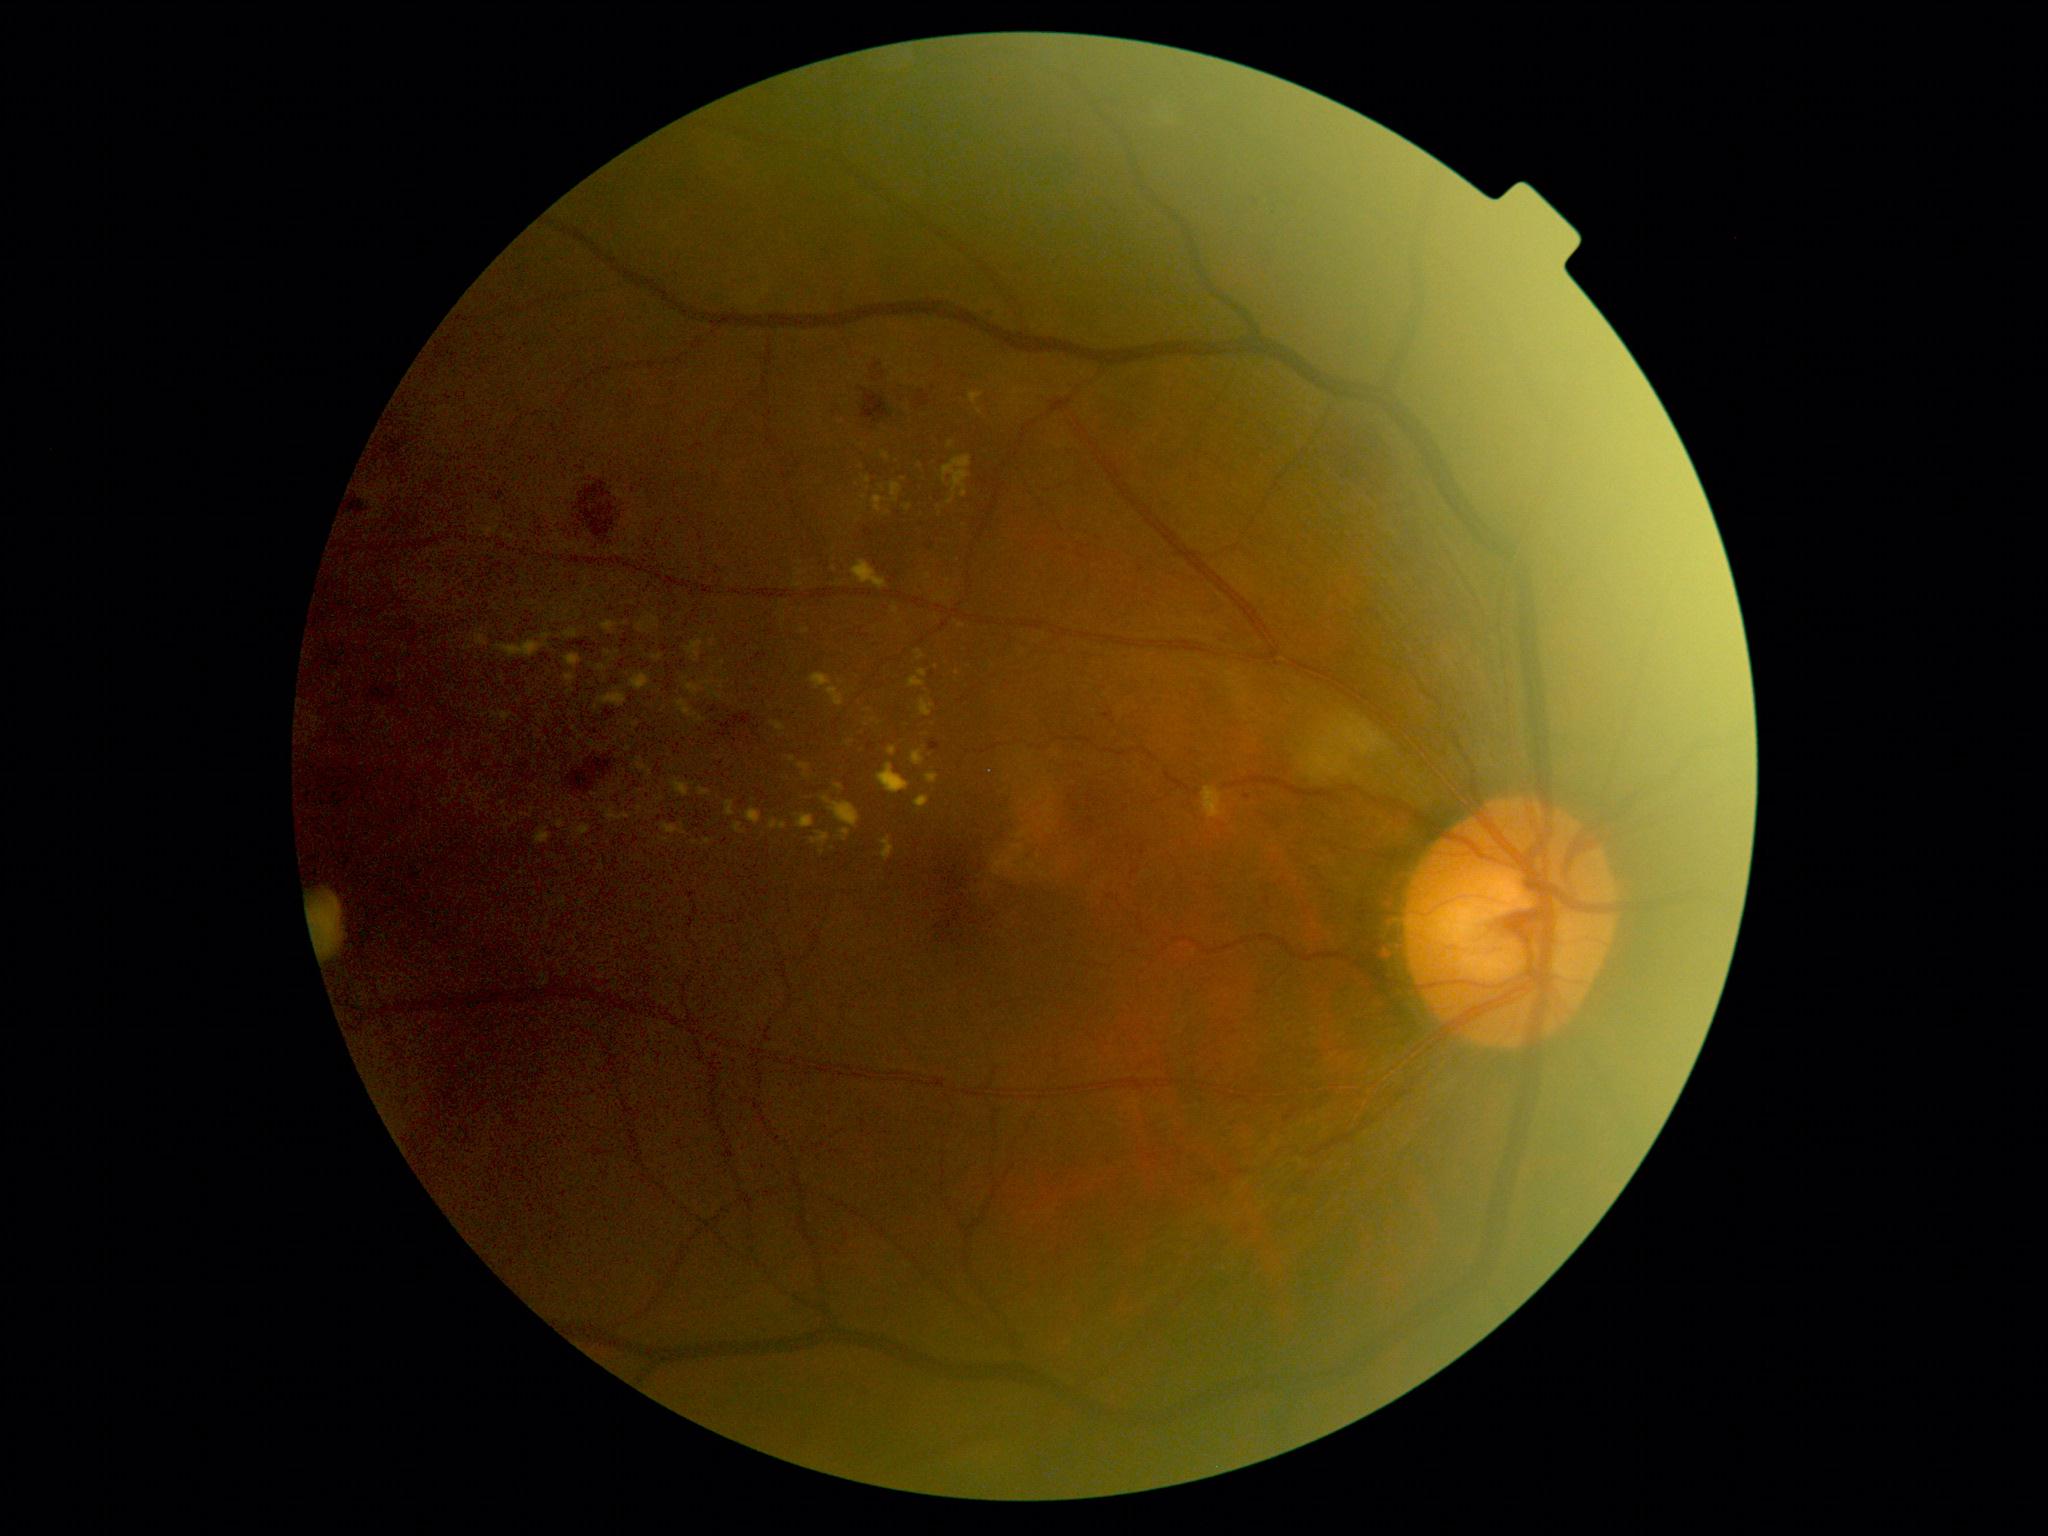 Diabetic retinopathy (DR) is grade 2 (moderate NPDR)
Lesions identified (partial list):
hard exudates (EXs) (more not shown) = bbox(748, 810, 761, 825) | bbox(853, 562, 886, 588) | bbox(601, 695, 627, 707) | bbox(501, 712, 511, 722) | bbox(799, 764, 808, 770) | bbox(566, 655, 582, 666) | bbox(874, 496, 882, 511) | bbox(566, 630, 578, 637) | bbox(812, 675, 831, 688) | bbox(919, 671, 928, 678) | bbox(913, 751, 923, 766)
Additional small EXs near x=908 y=509 | x=629 y=749 | x=964 y=495 | x=840 y=788 | x=739 y=828